Davis DR grading: 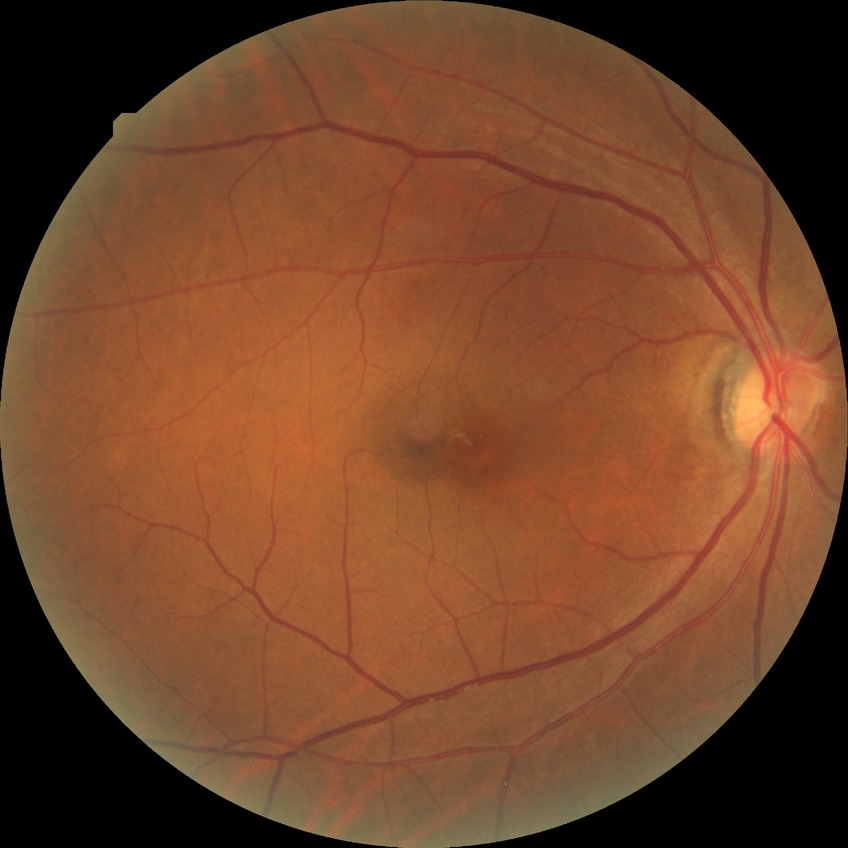 diabetic retinopathy (DR): NDR (no diabetic retinopathy).